Camera: Topcon TRC-50DX — 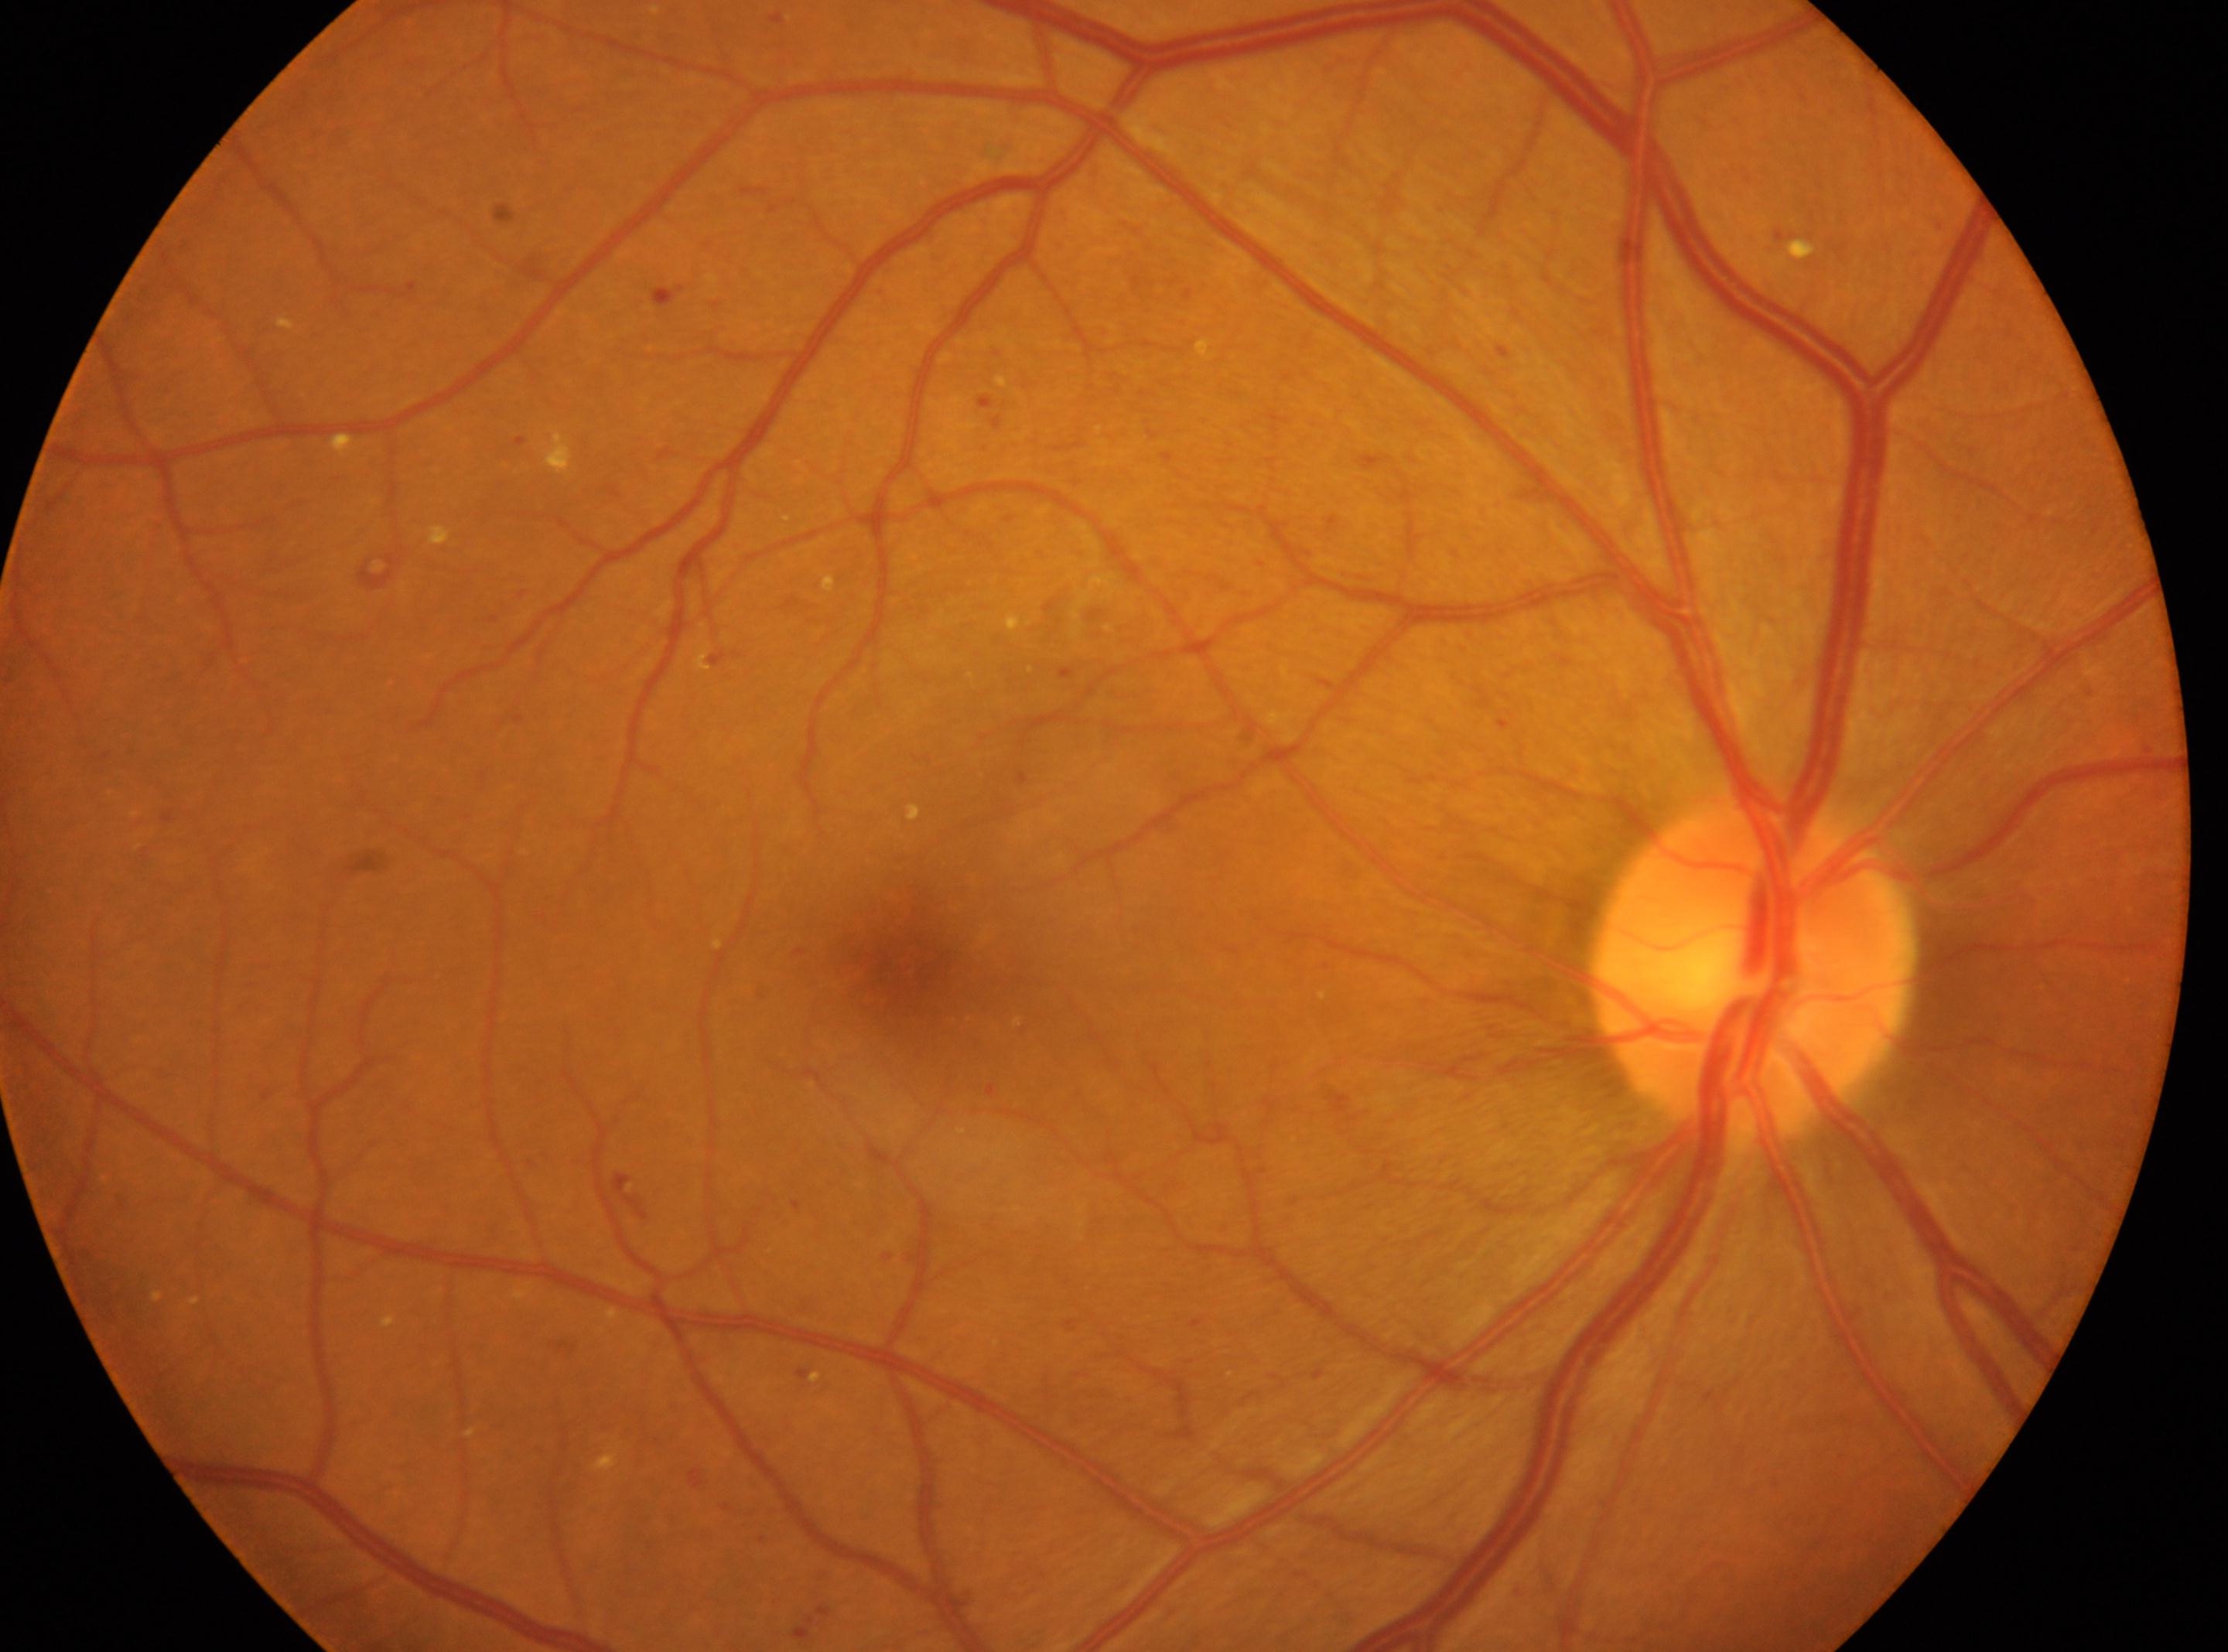

| feature | annotation |
|---|---|
| diabetic retinopathy severity | moderate non-proliferative diabetic retinopathy (grade 2) |
| ONH | (x=1752, y=967) |
| laterality | oculus dexter |
| fovea centralis | (x=907, y=961) |